Infant wide-field retinal image · captured with the Natus RetCam Envision (130° field of view) · 1440x1080: 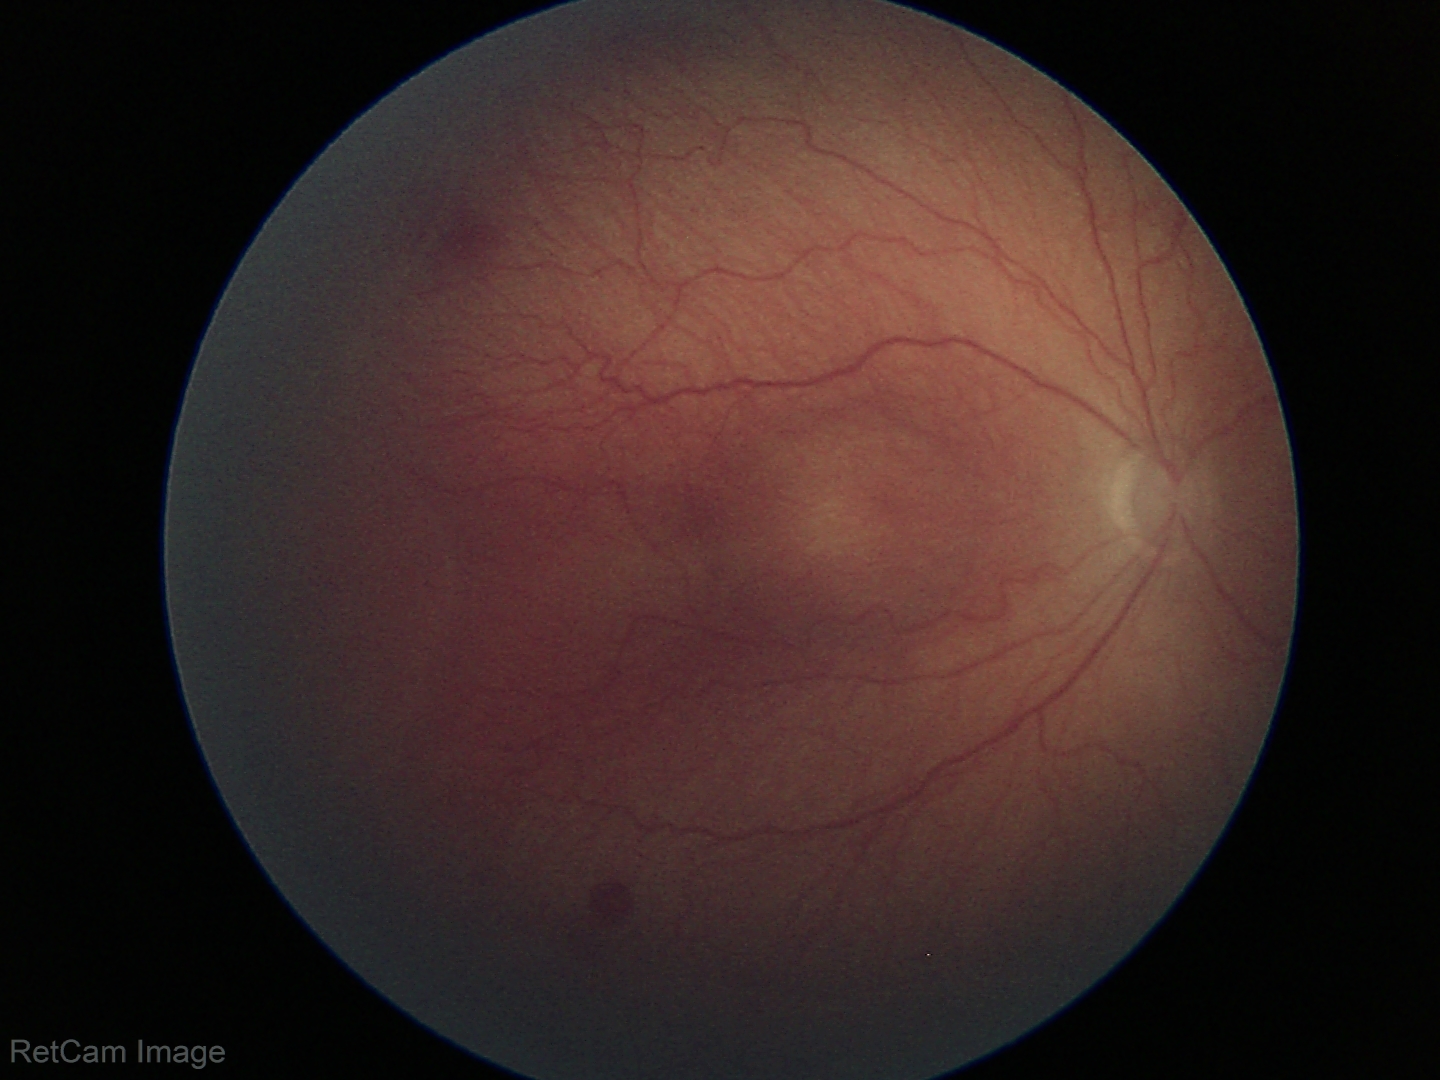

Diagnosis = ROP stage 2 — ridge with height and width at the demarcation line
plus form = absent